Infant wide-field fundus photograph:
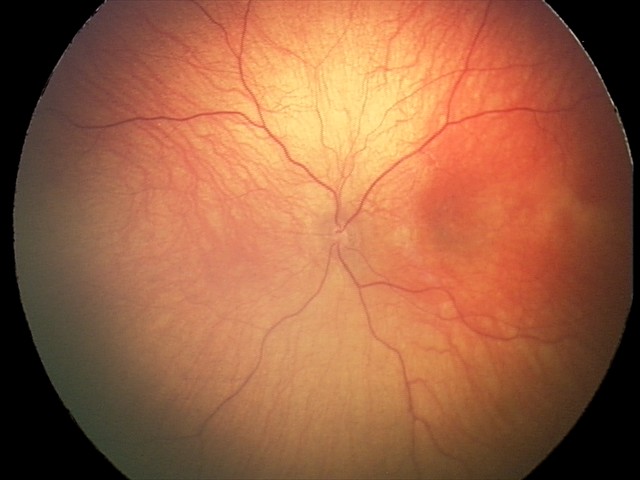
Screening examination diagnosed as physiological.